Wide-field fundus image from infant ROP screening; camera: Clarity RetCam 3 (130° FOV) — 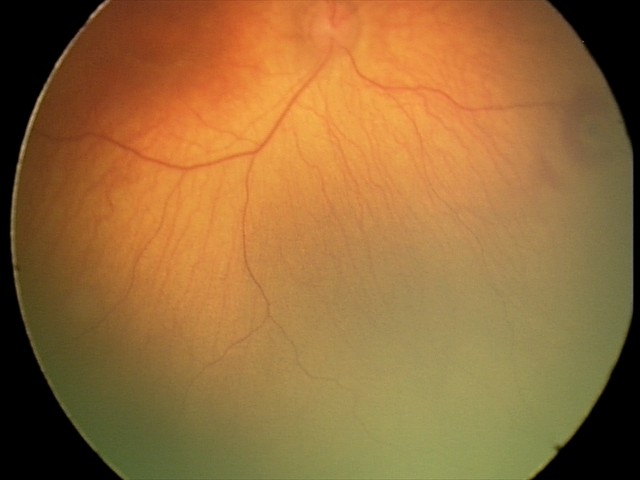 Screening: retinal hemorrhages.